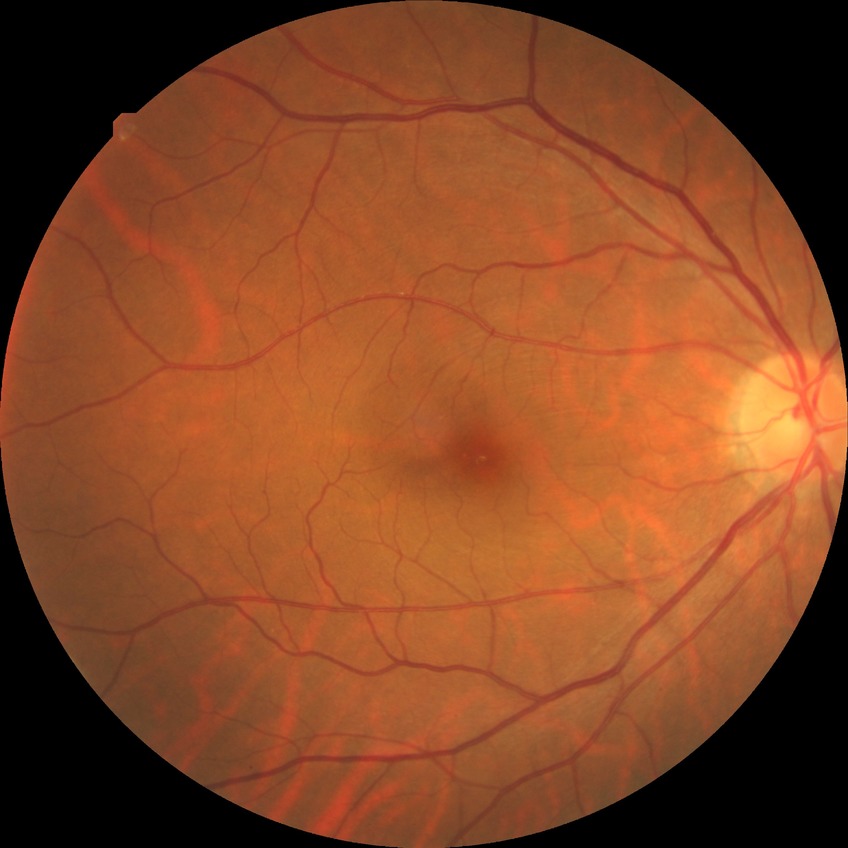
No apparent diabetic retinopathy. DR grade is NDR.